FOV: 45 degrees — 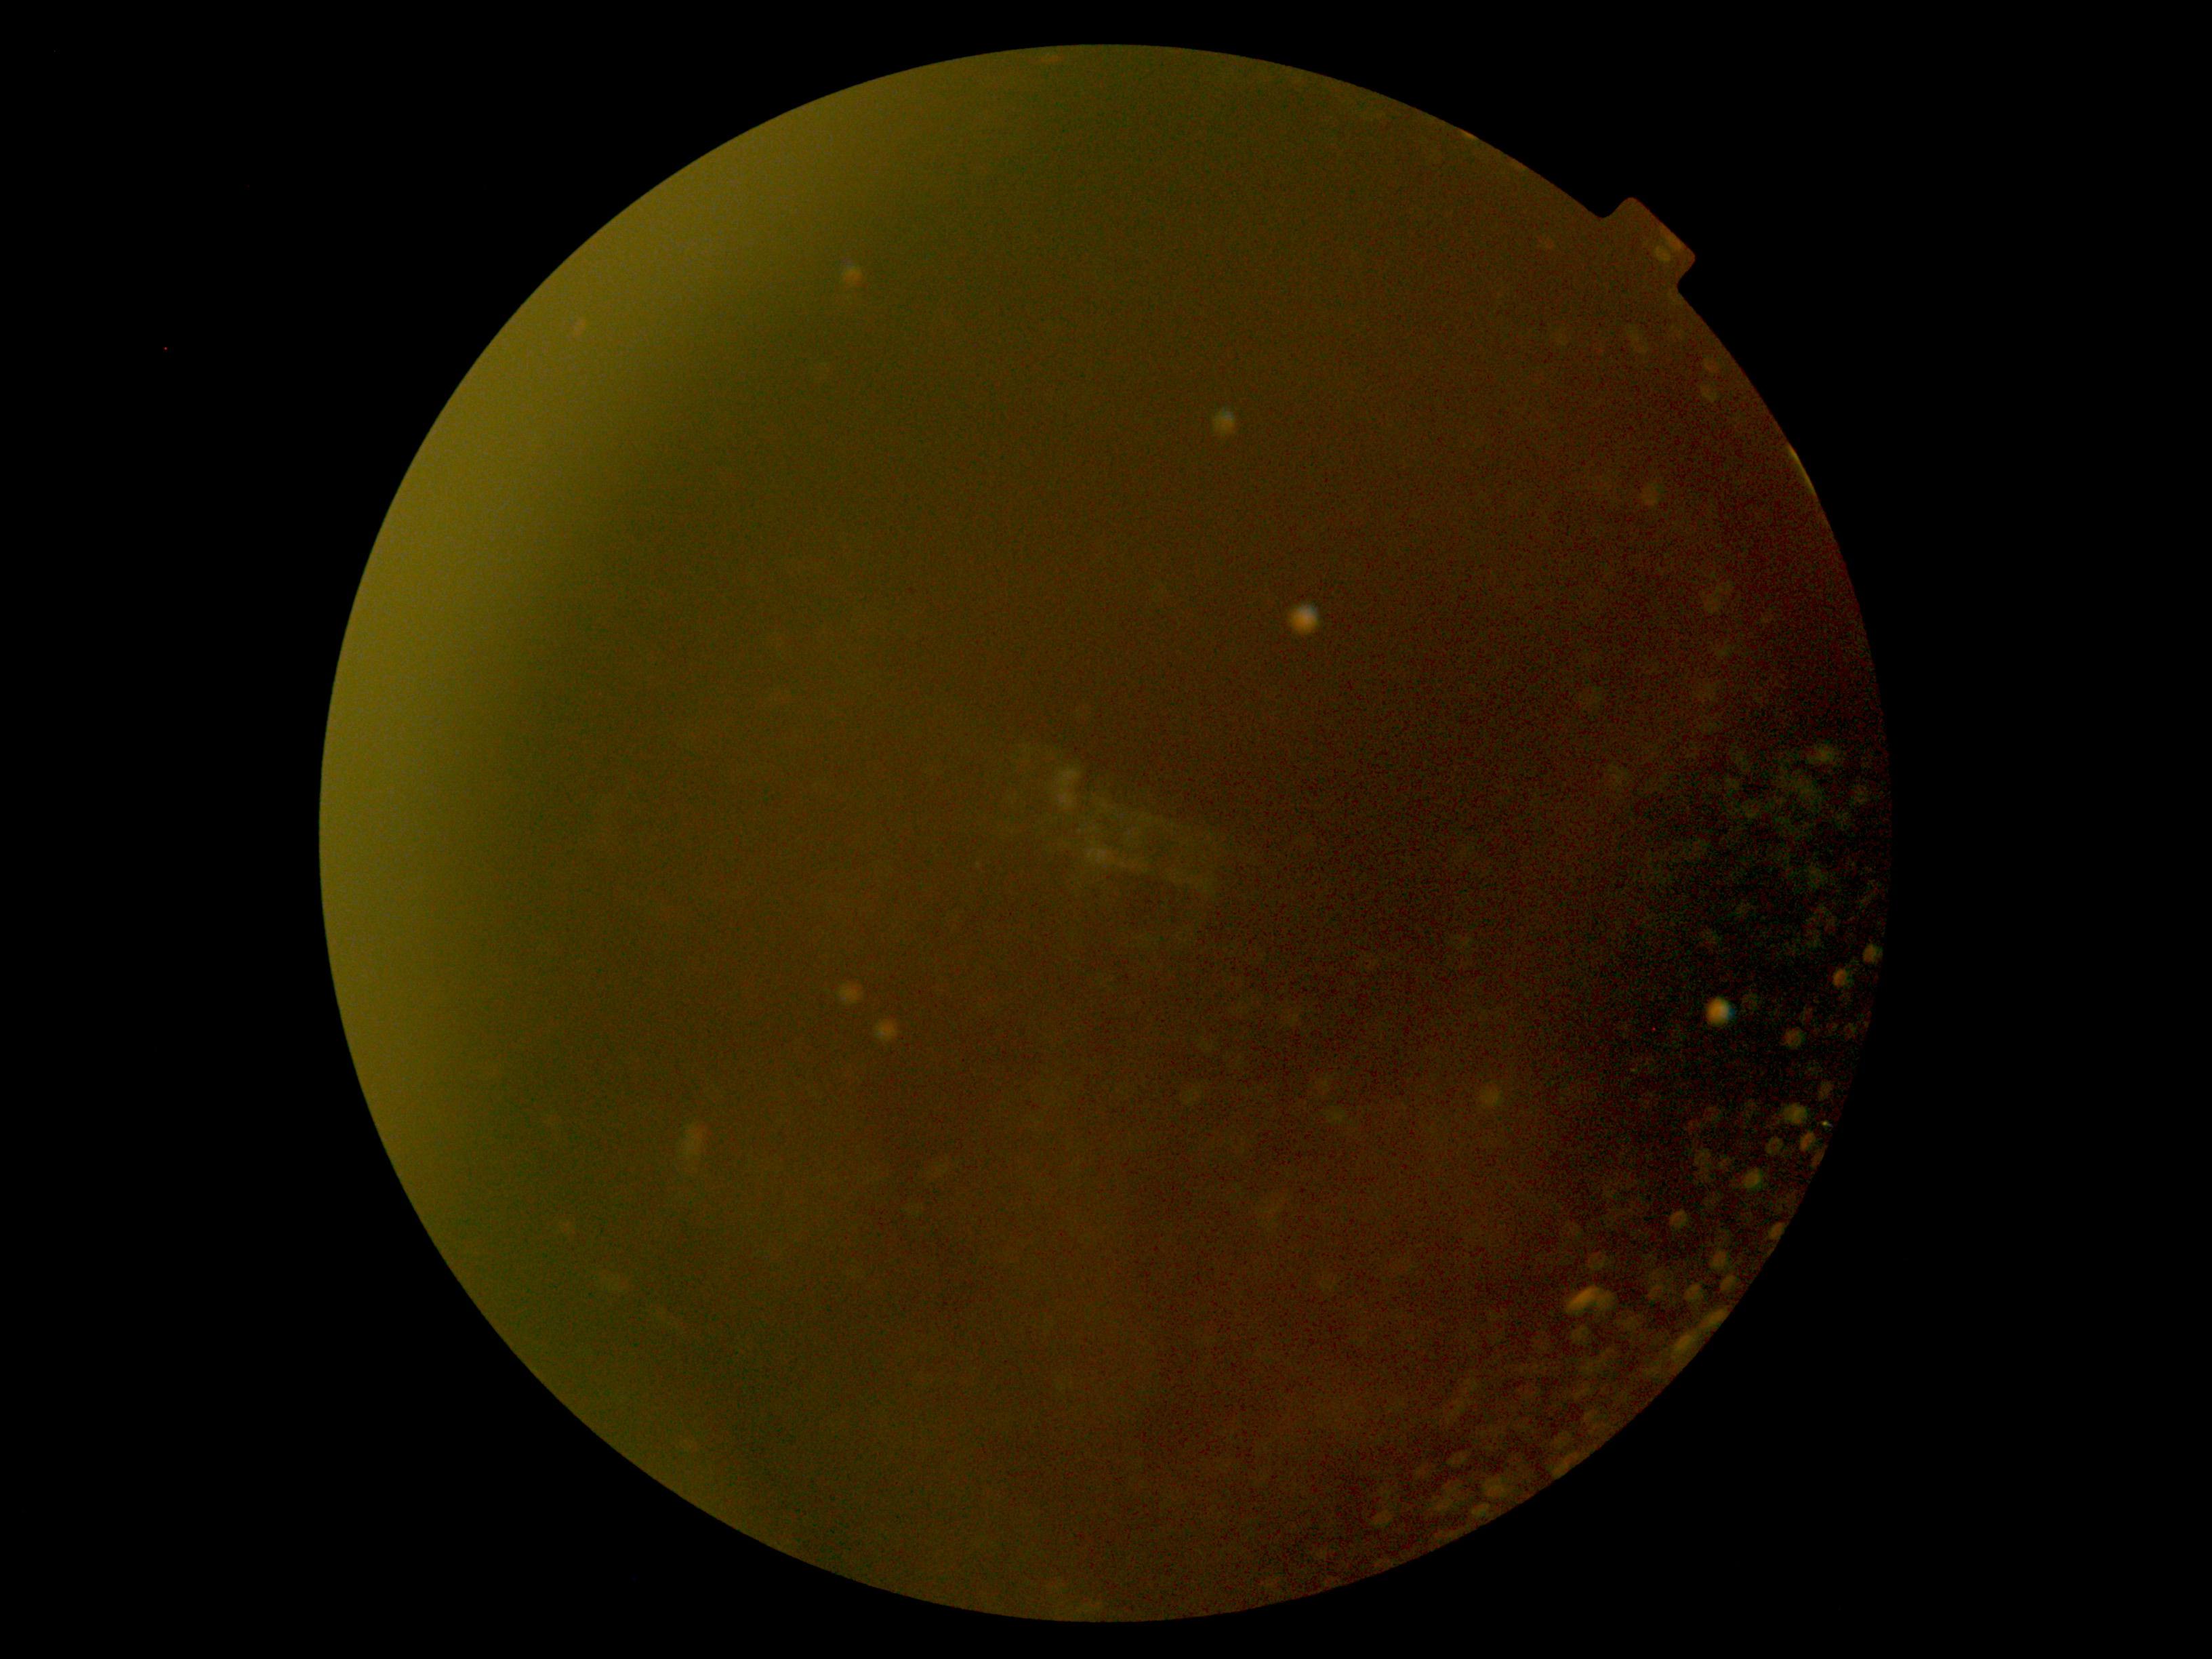

{"dr_grade": "ungradable", "quality": "insufficient for DR assessment"}